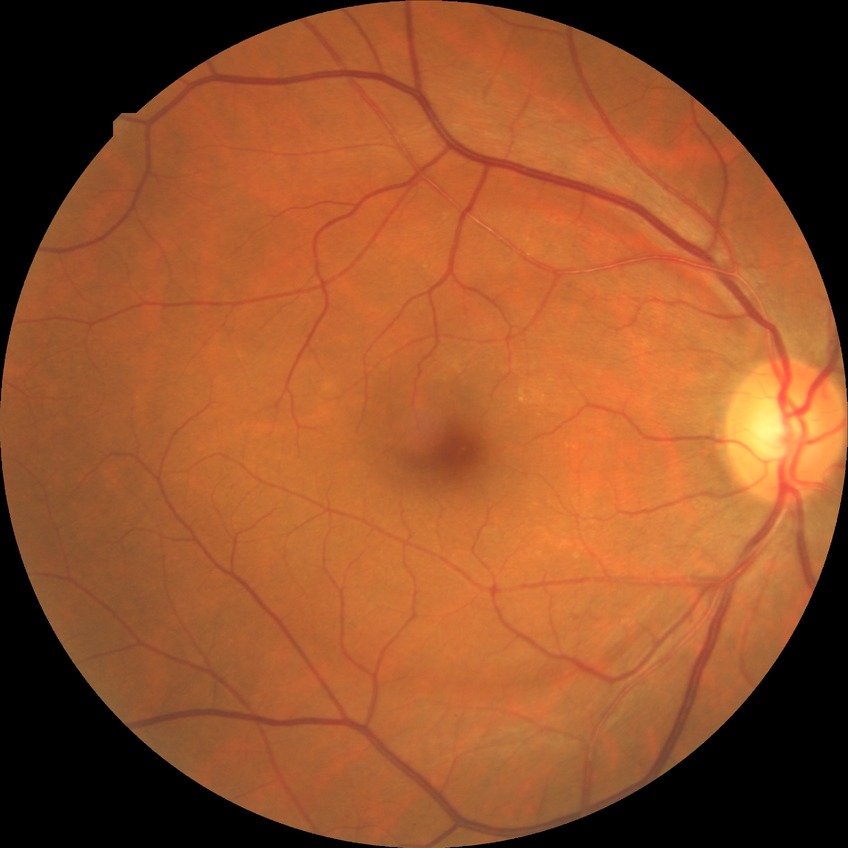 The retinopathy is classified as non-proliferative diabetic retinopathy.
Diabetic retinopathy (DR): SDR (simple diabetic retinopathy).